Color fundus photograph; 2184x1690 — 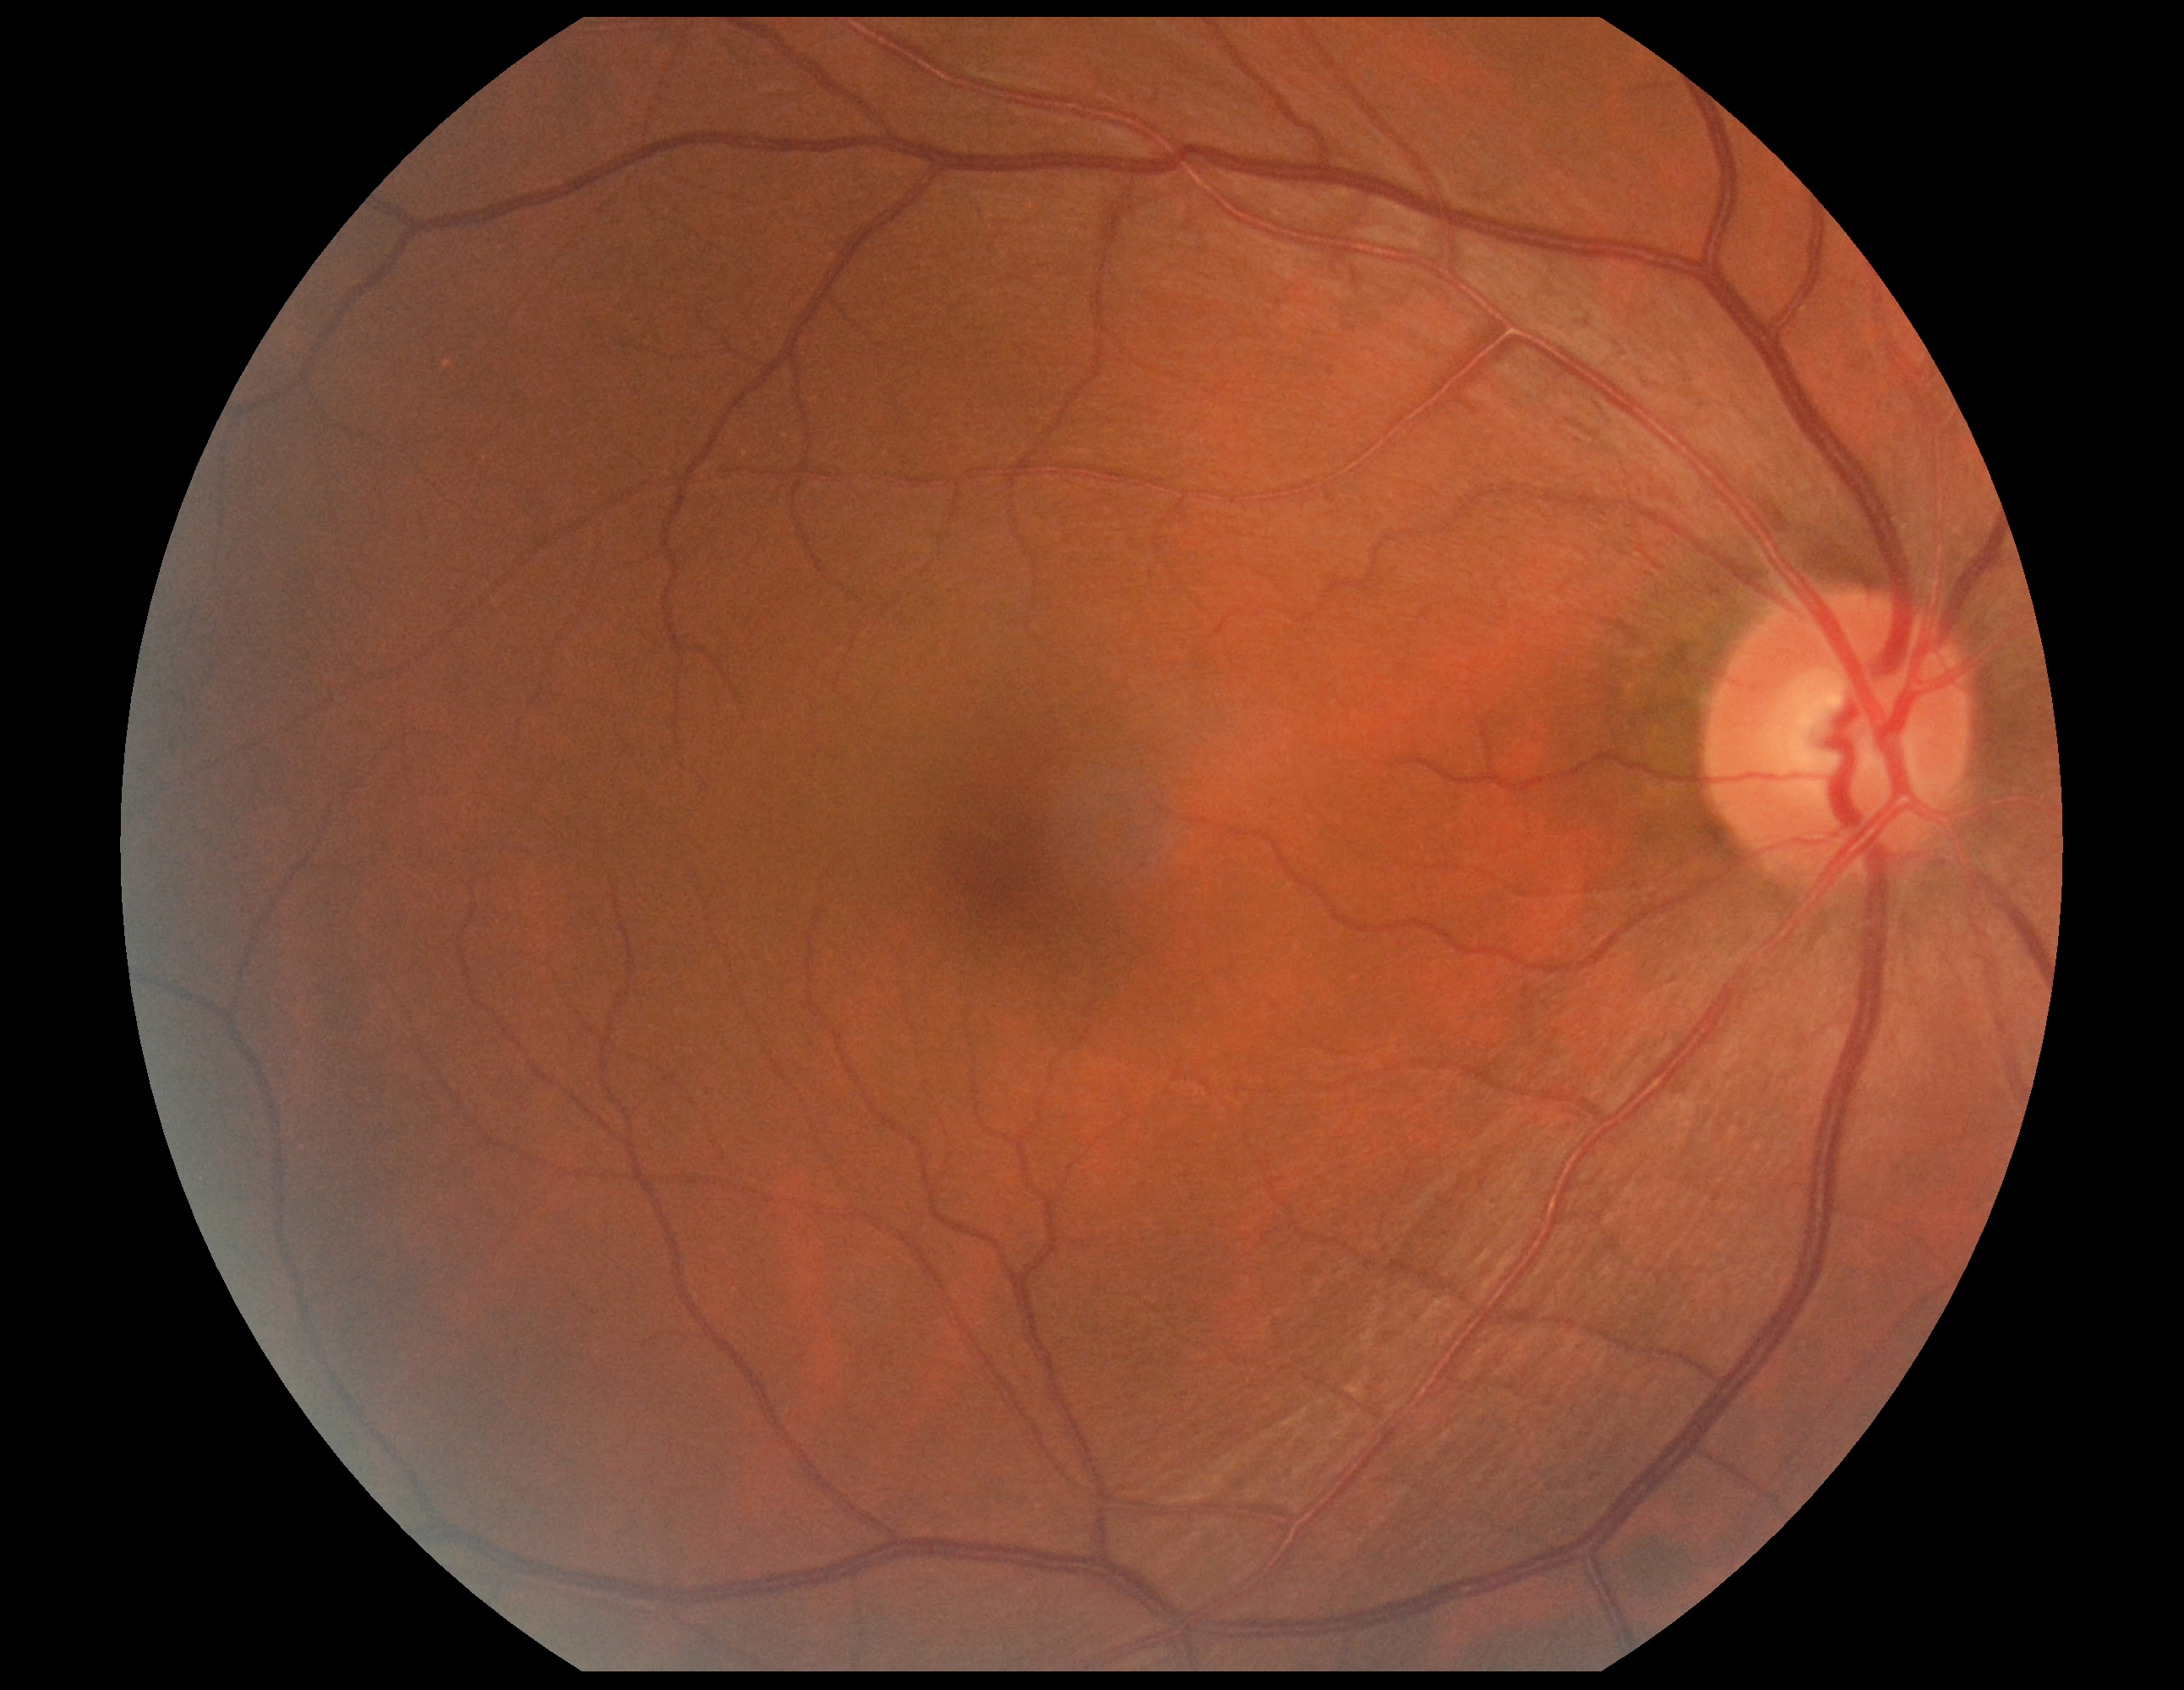 DR severity: grade 0 (no apparent retinopathy).